45° FOV. Tabletop color fundus camera image. 412x310px: 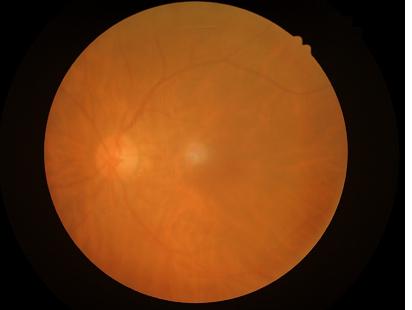 The image is blurry. Contrast is low. Overall quality is poor; the image is difficult to grade.